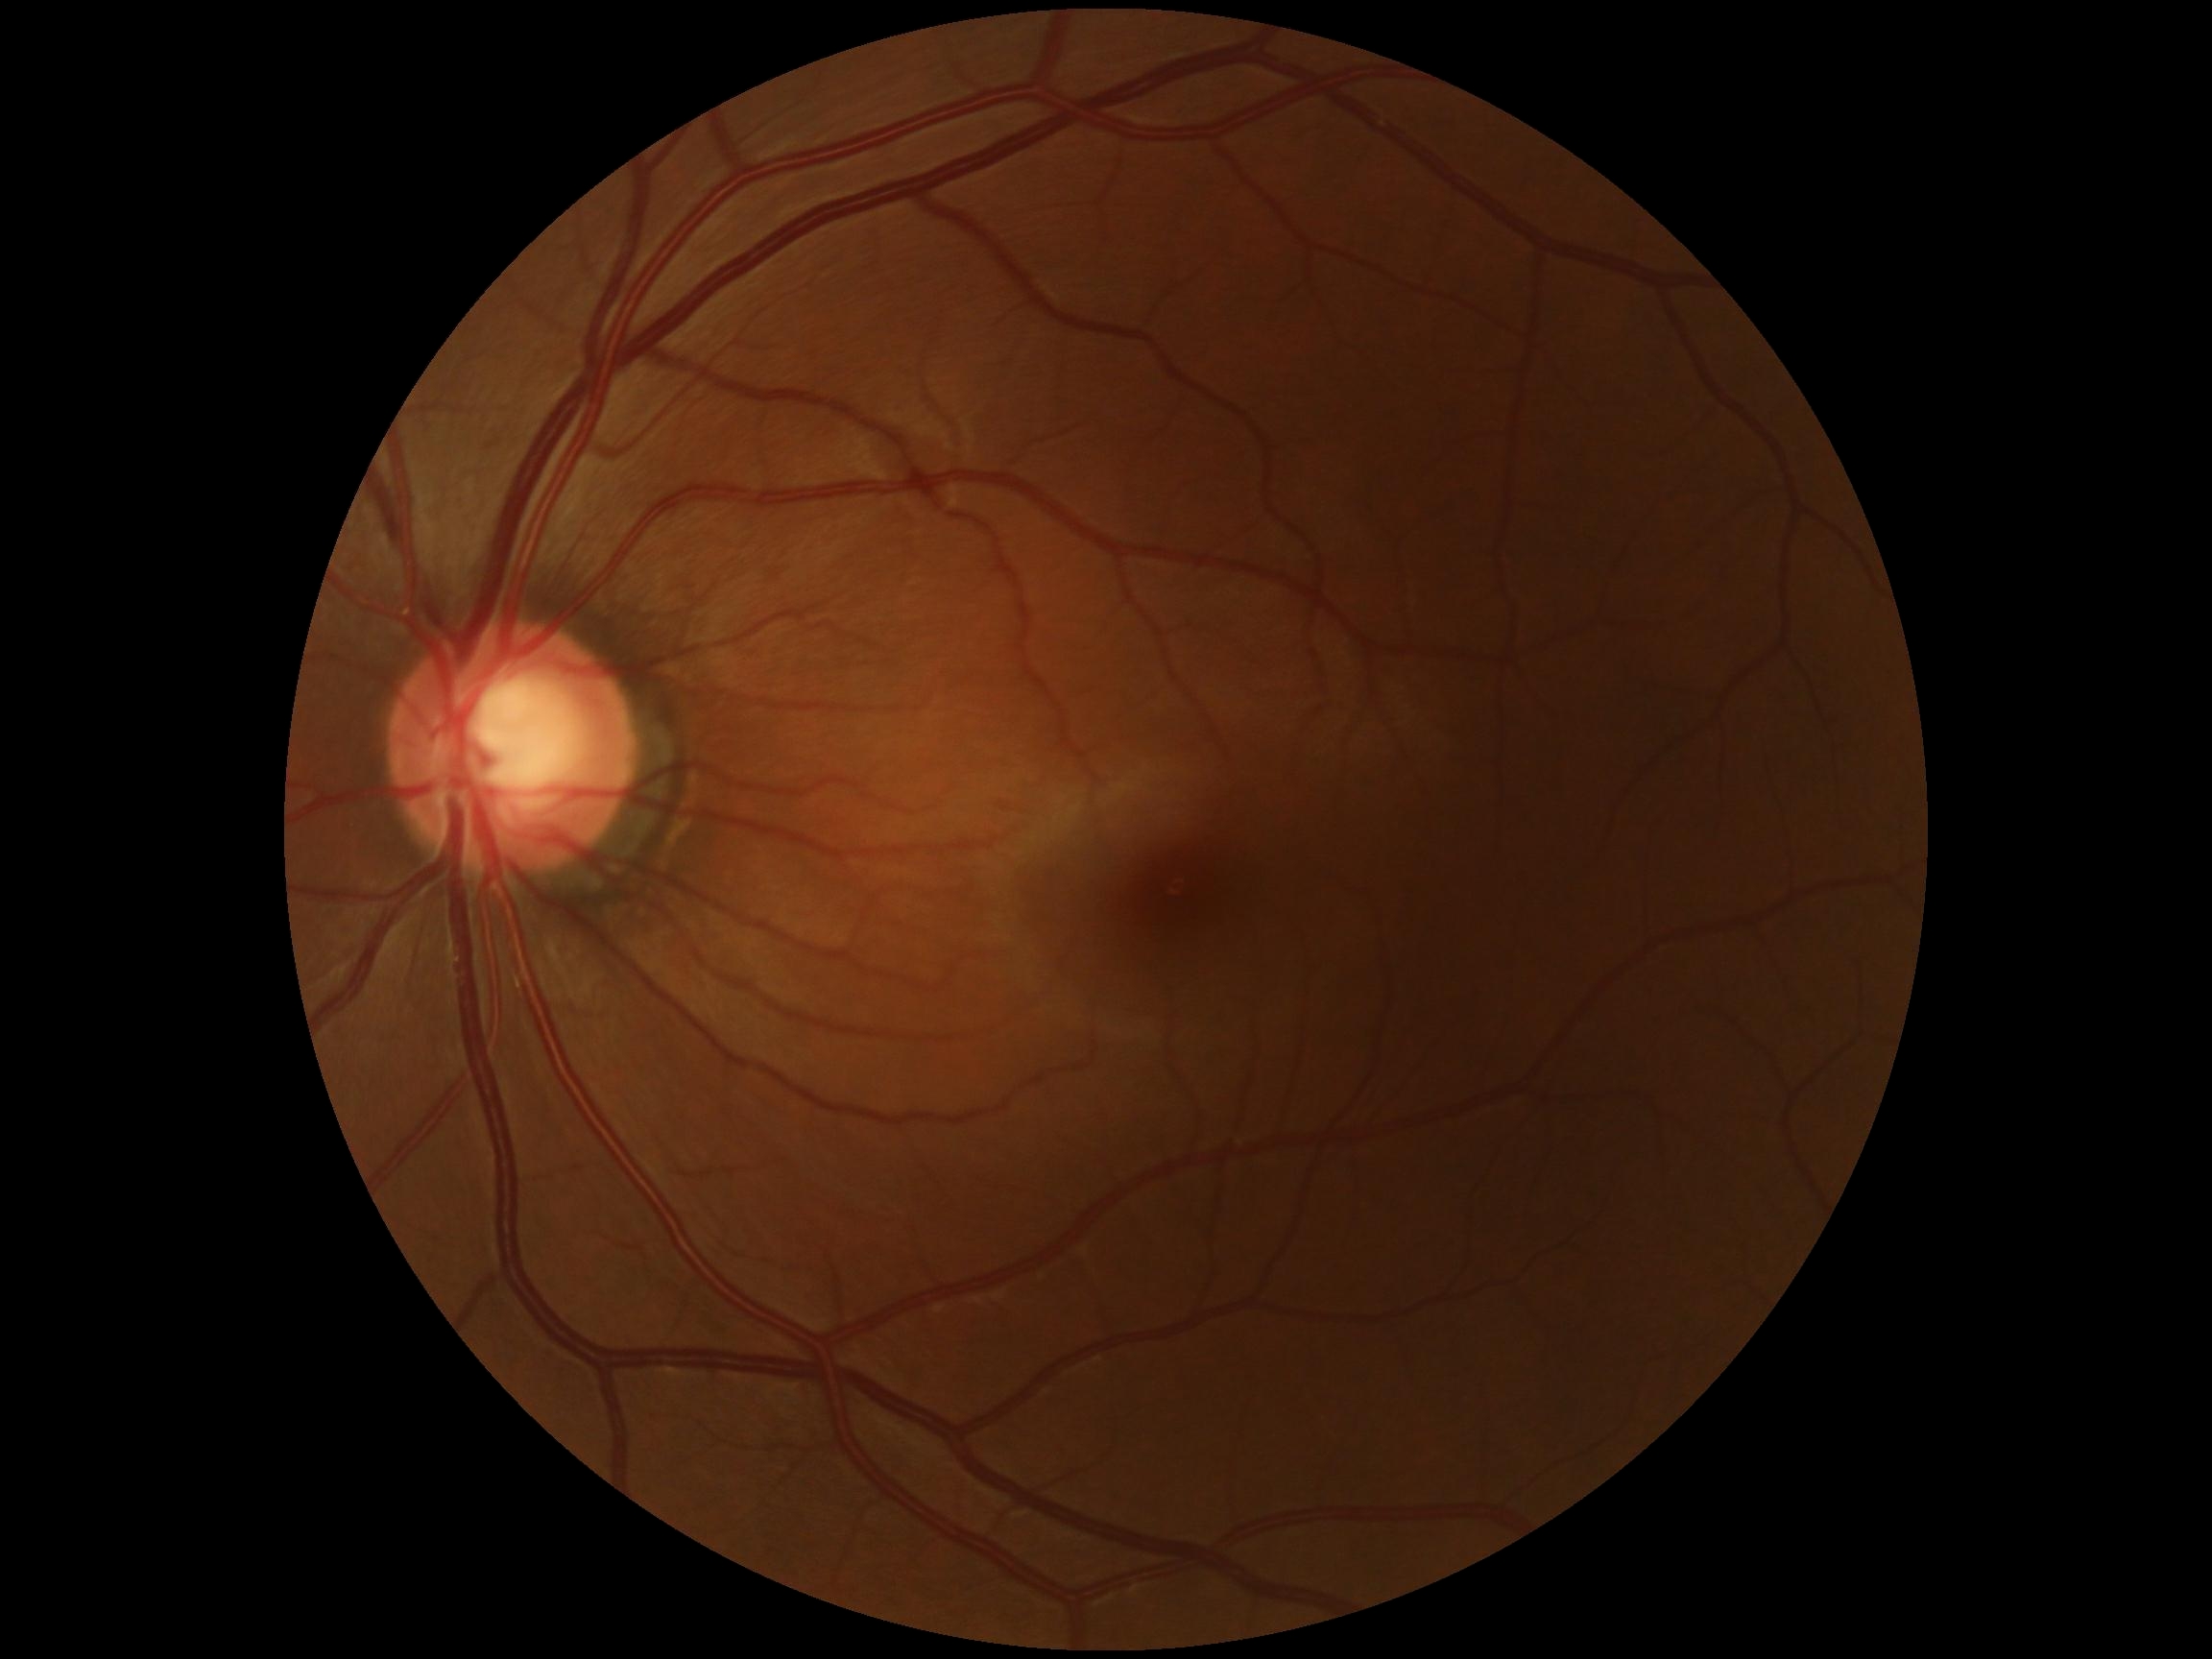
{"dr_impression": "negative for DR", "dr_grade": "0"}